FOV: 45 degrees.
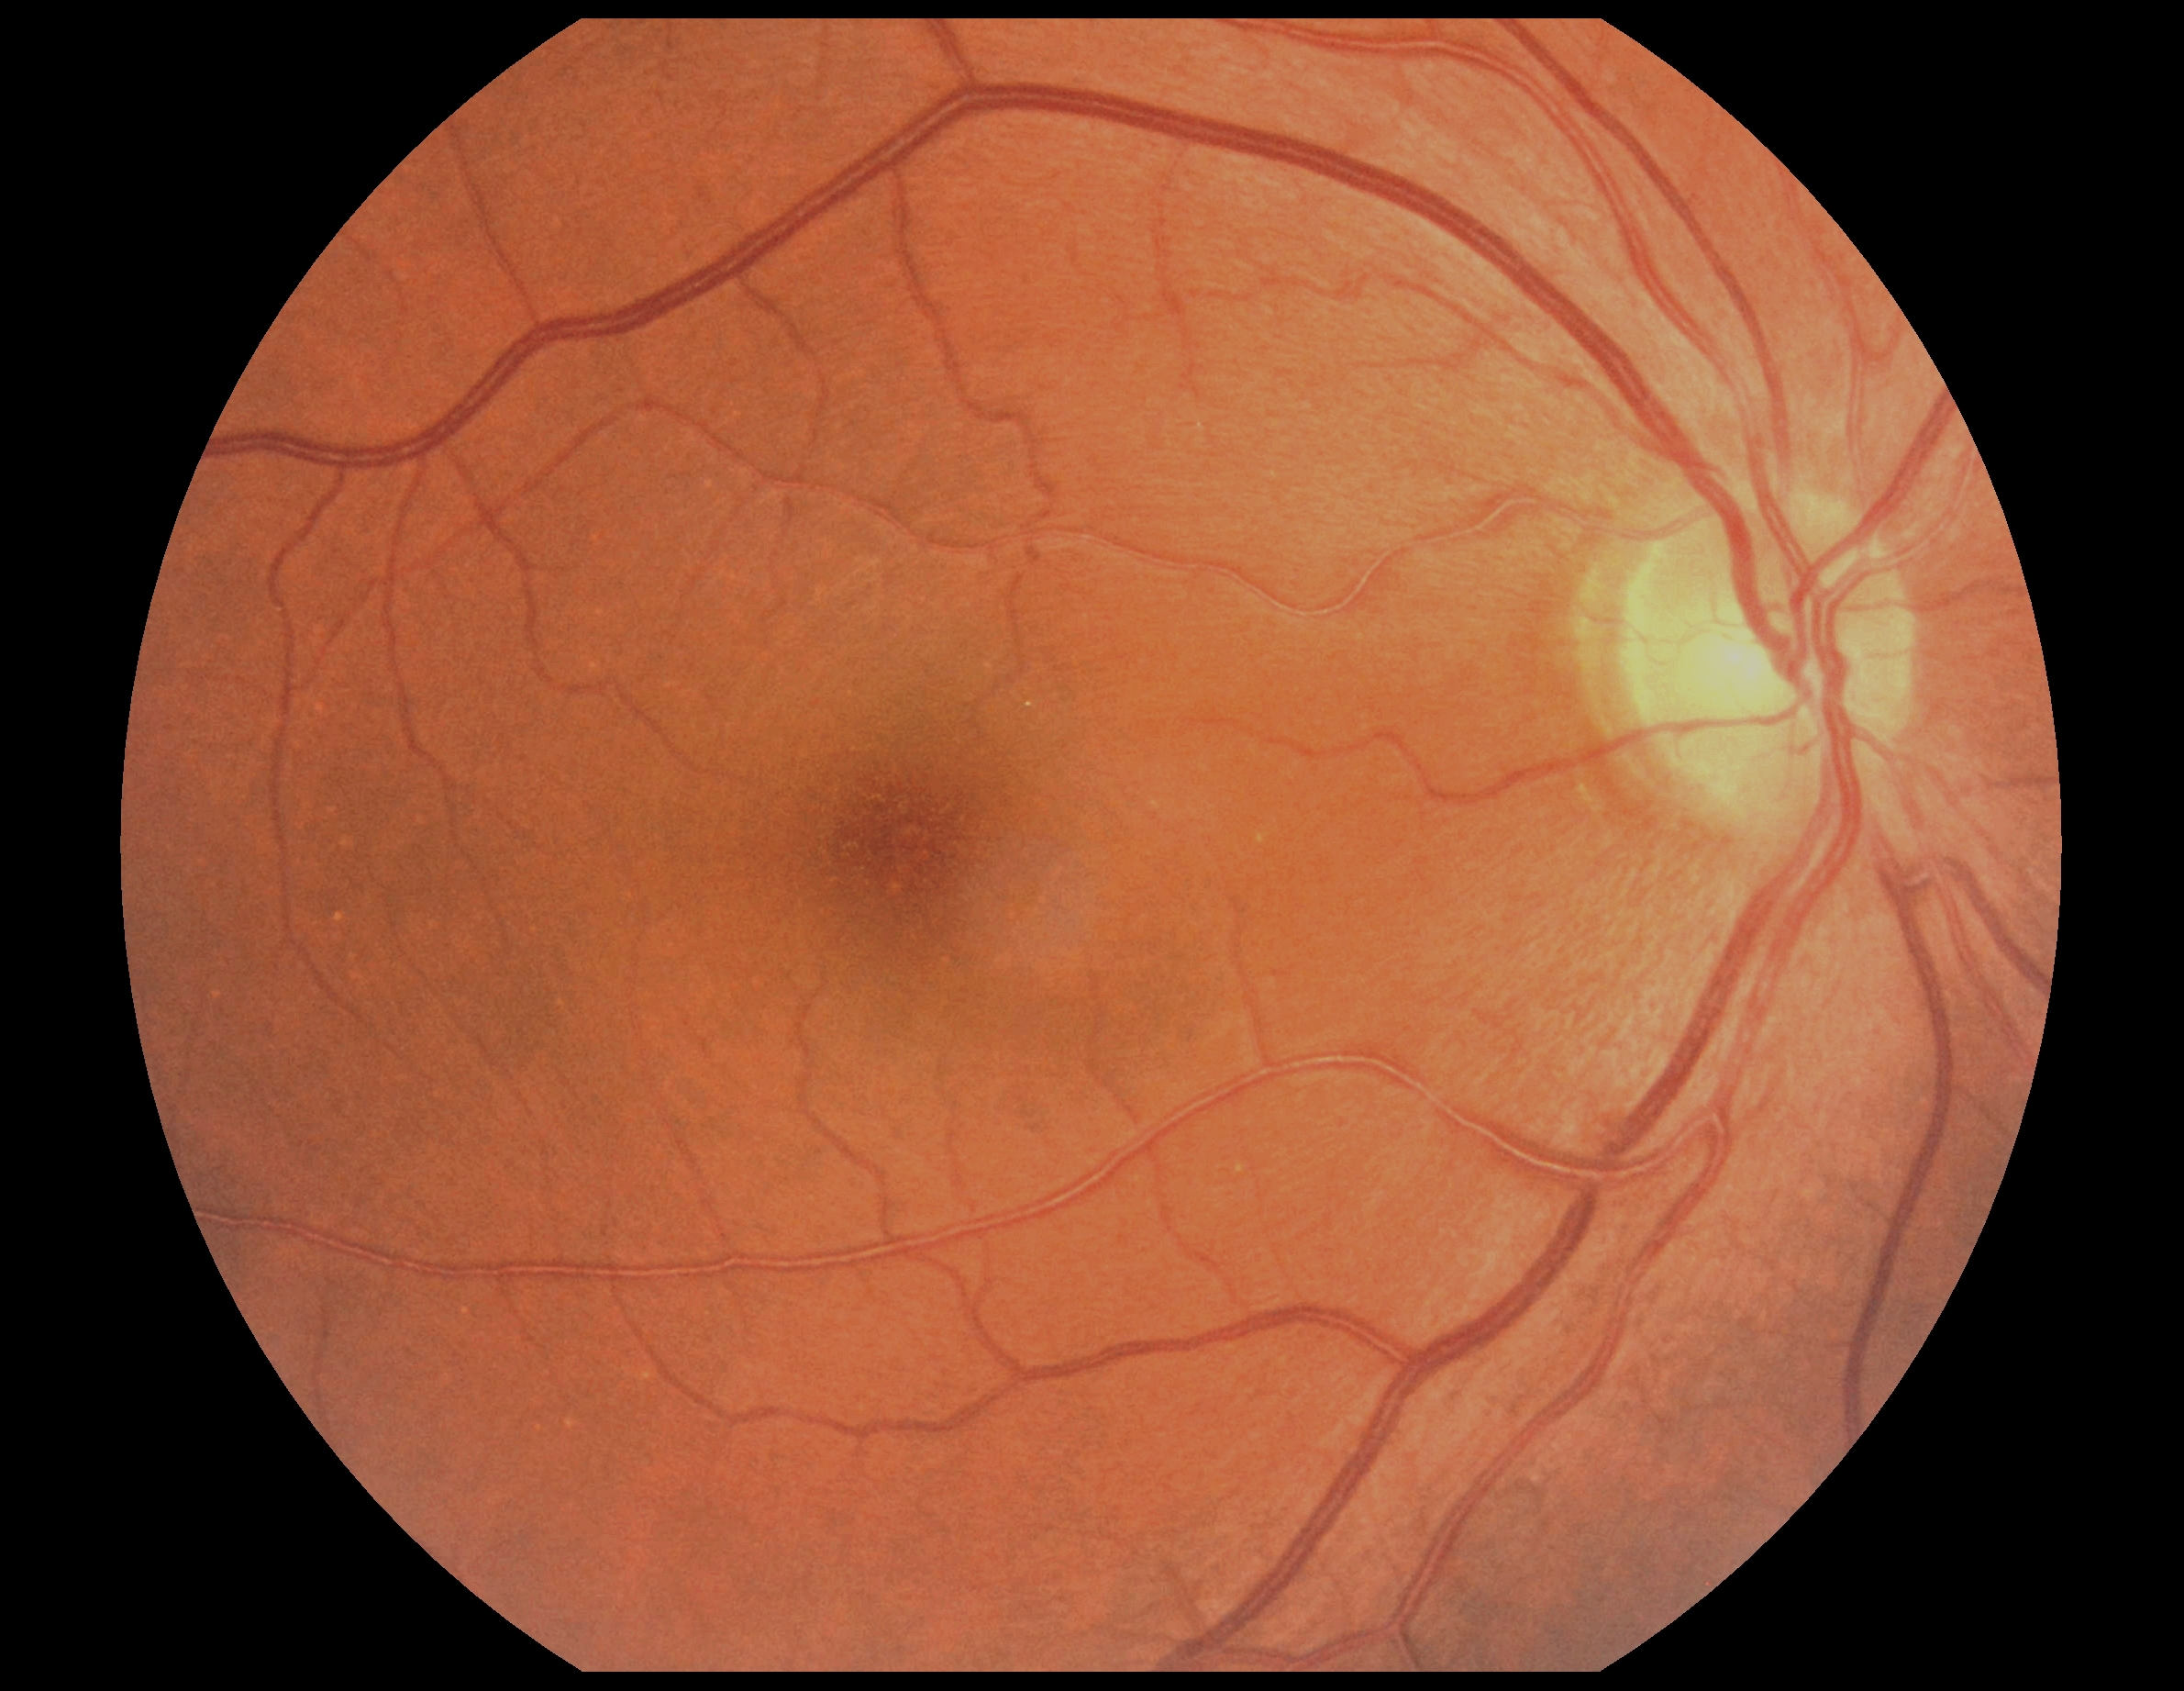

Diabetic retinopathy (DR): no apparent diabetic retinopathy (grade 0). No DR findings.